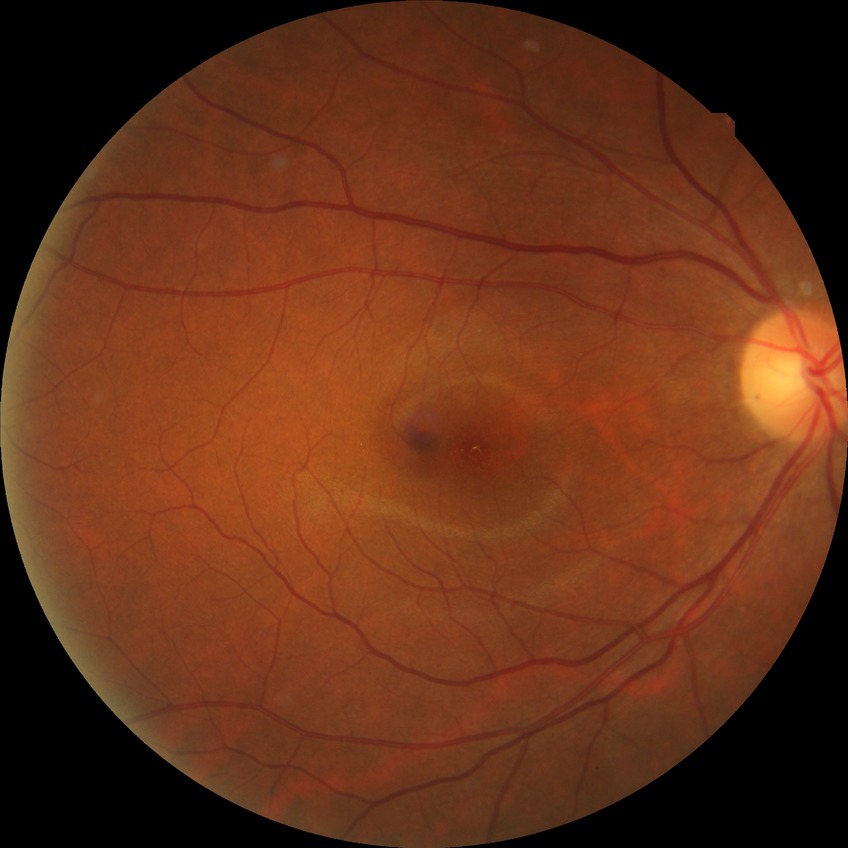
DR stage is NDR.